Pupil-dilated · 2228x1652px · camera: Topcon TRC-50DX · 50° FOV · posterior pole view · color fundus image:
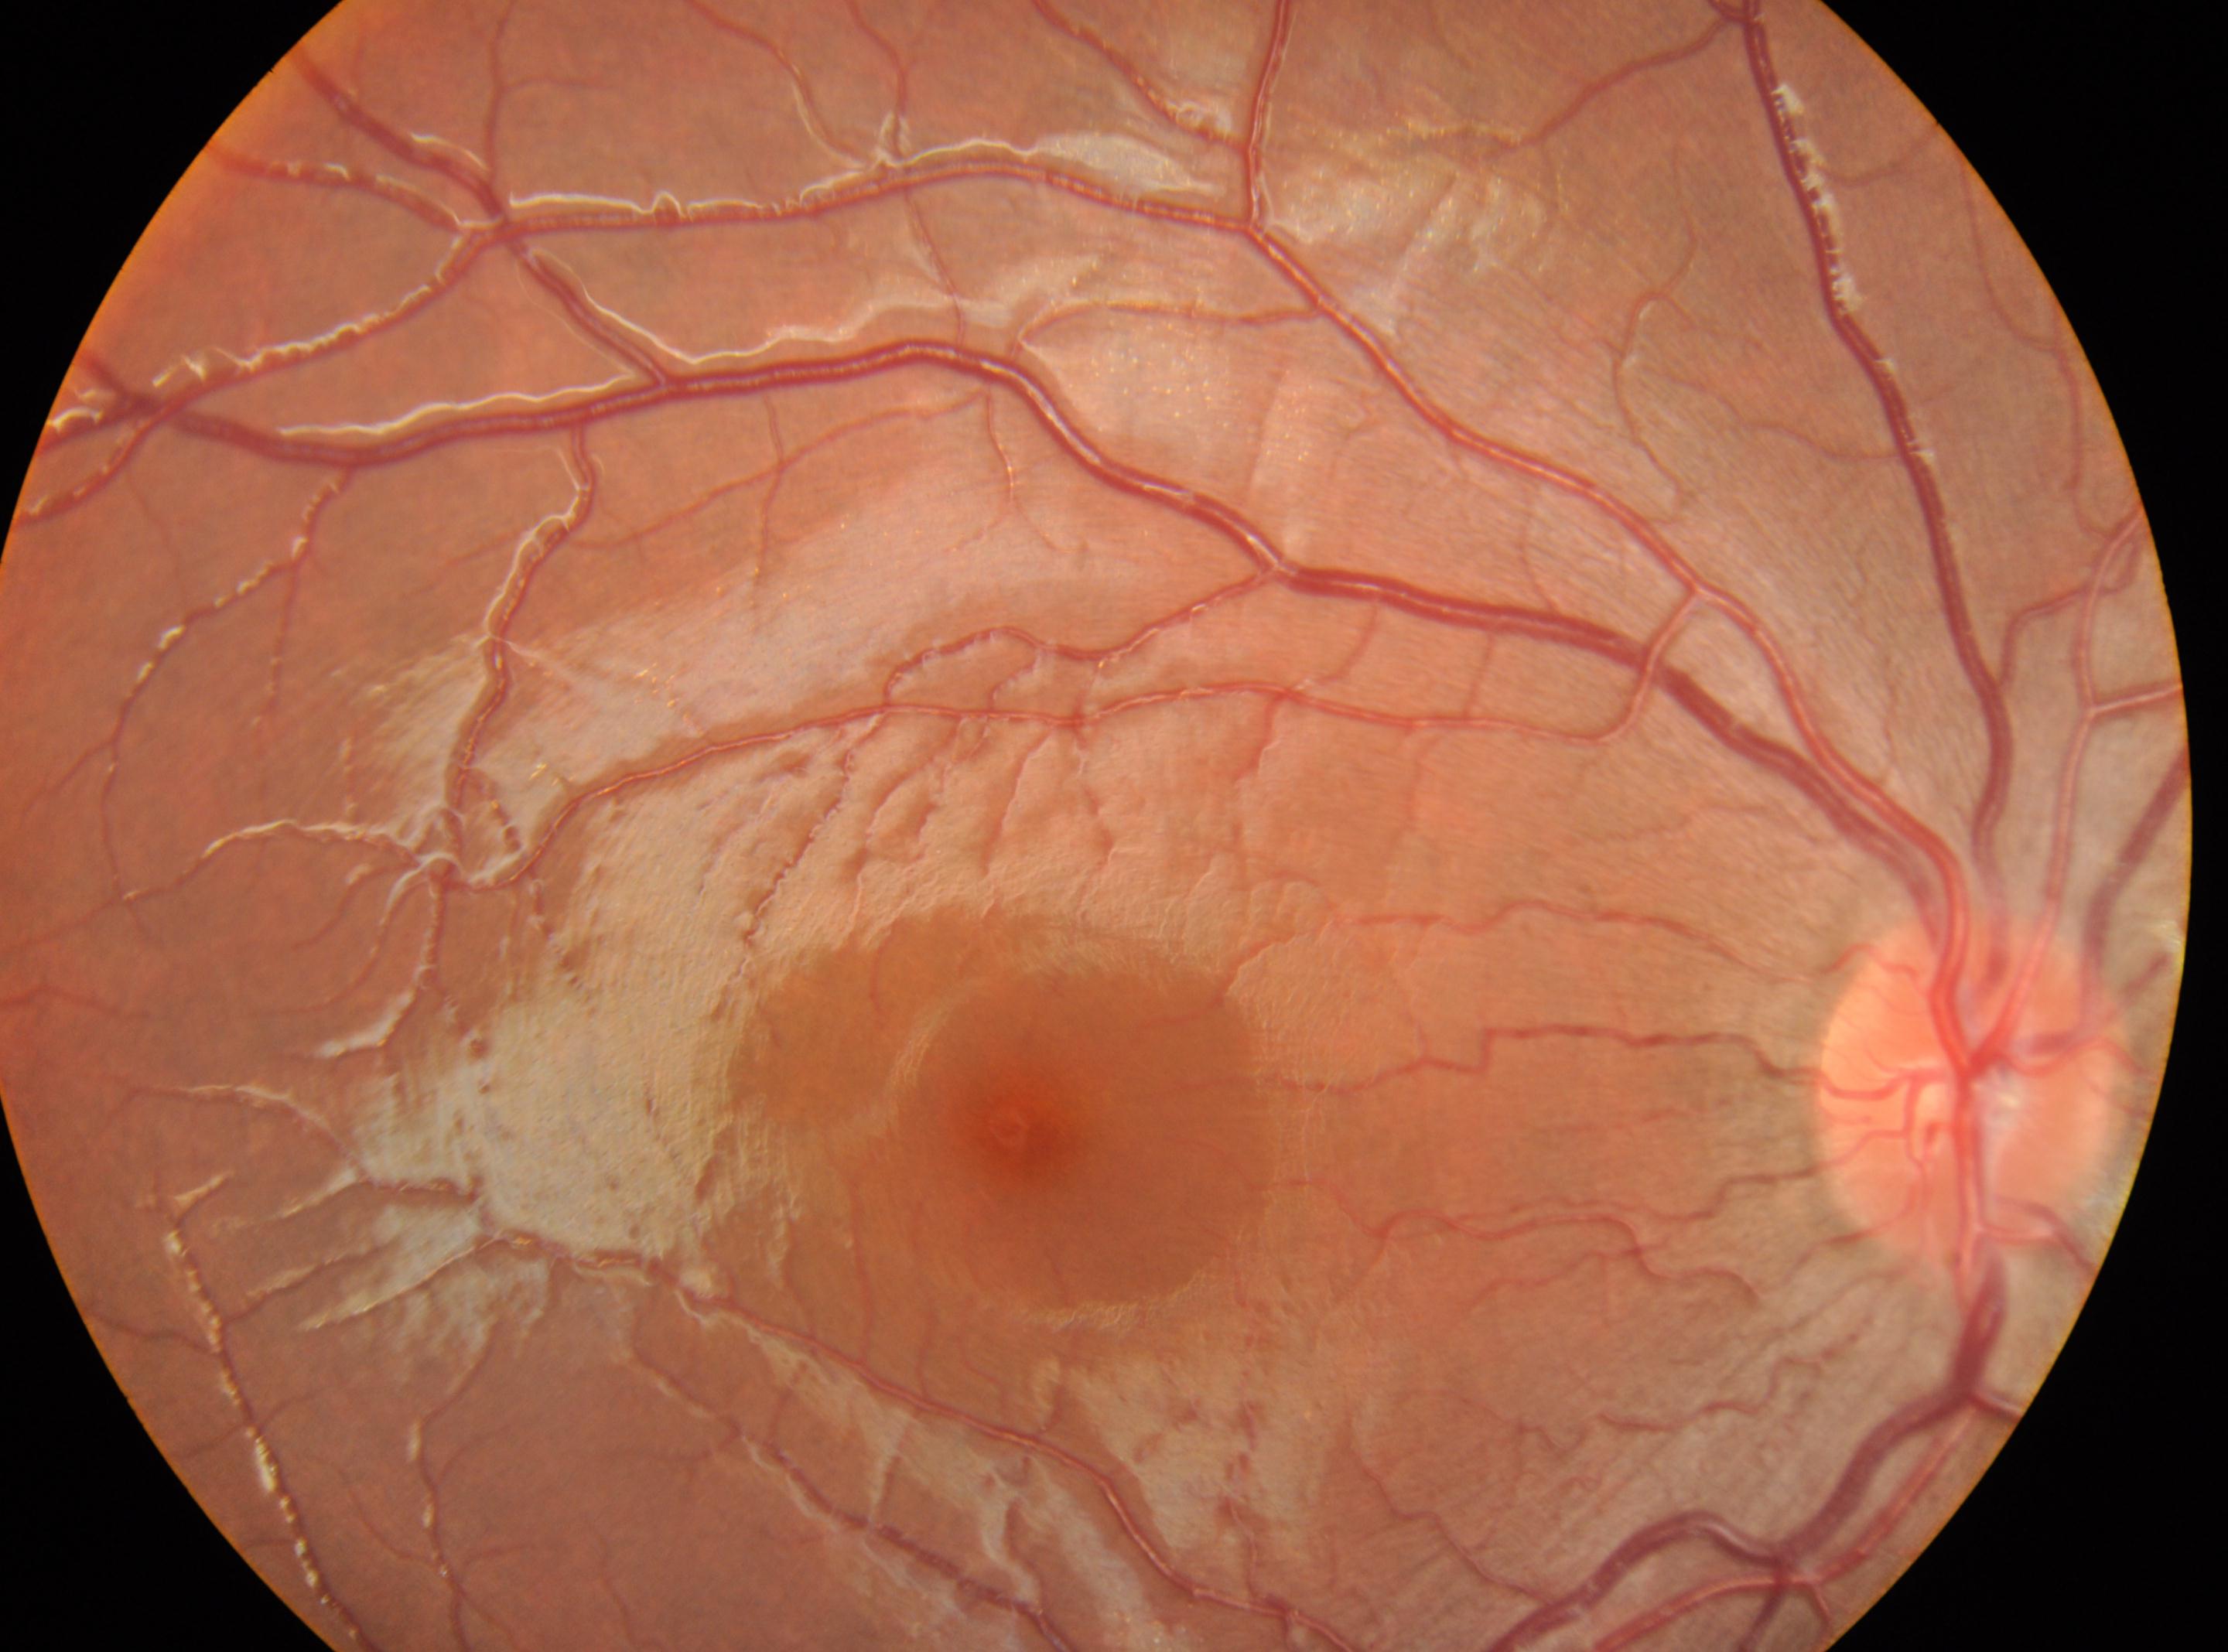
Fovea center located at [1021, 1128].
Diabetic retinopathy grade: 0.
The image shows the right eye.
The disc center is at [1972, 1084].
No diabetic retinal disease findings.